Davis DR grading: 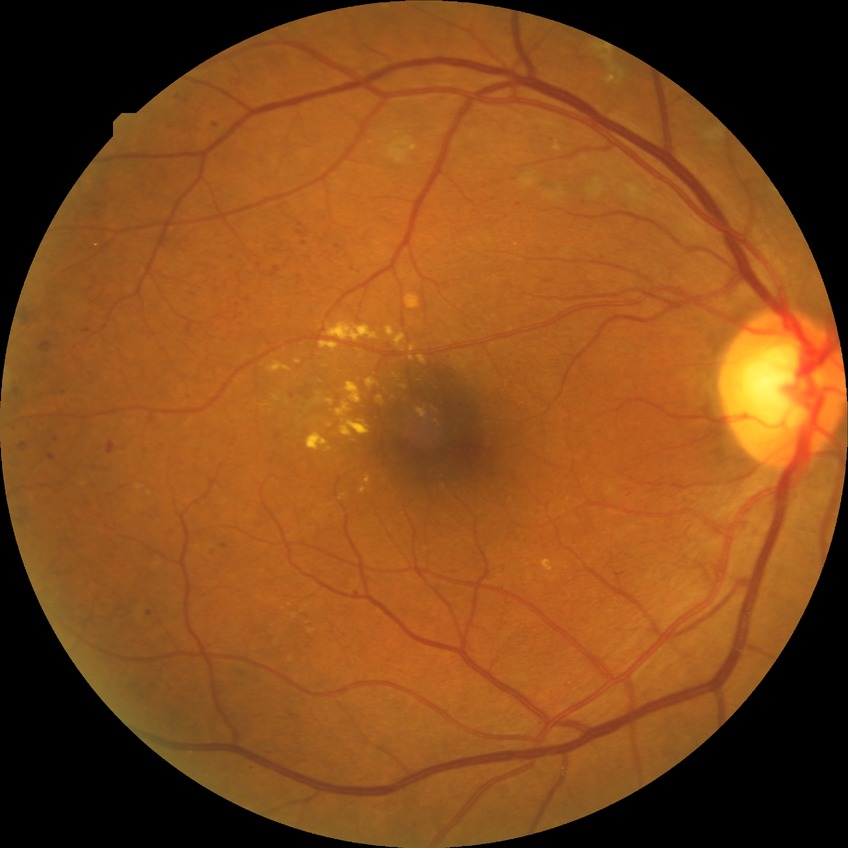
diabetic retinopathy (DR)=PDR (proliferative diabetic retinopathy).